2352x1568px
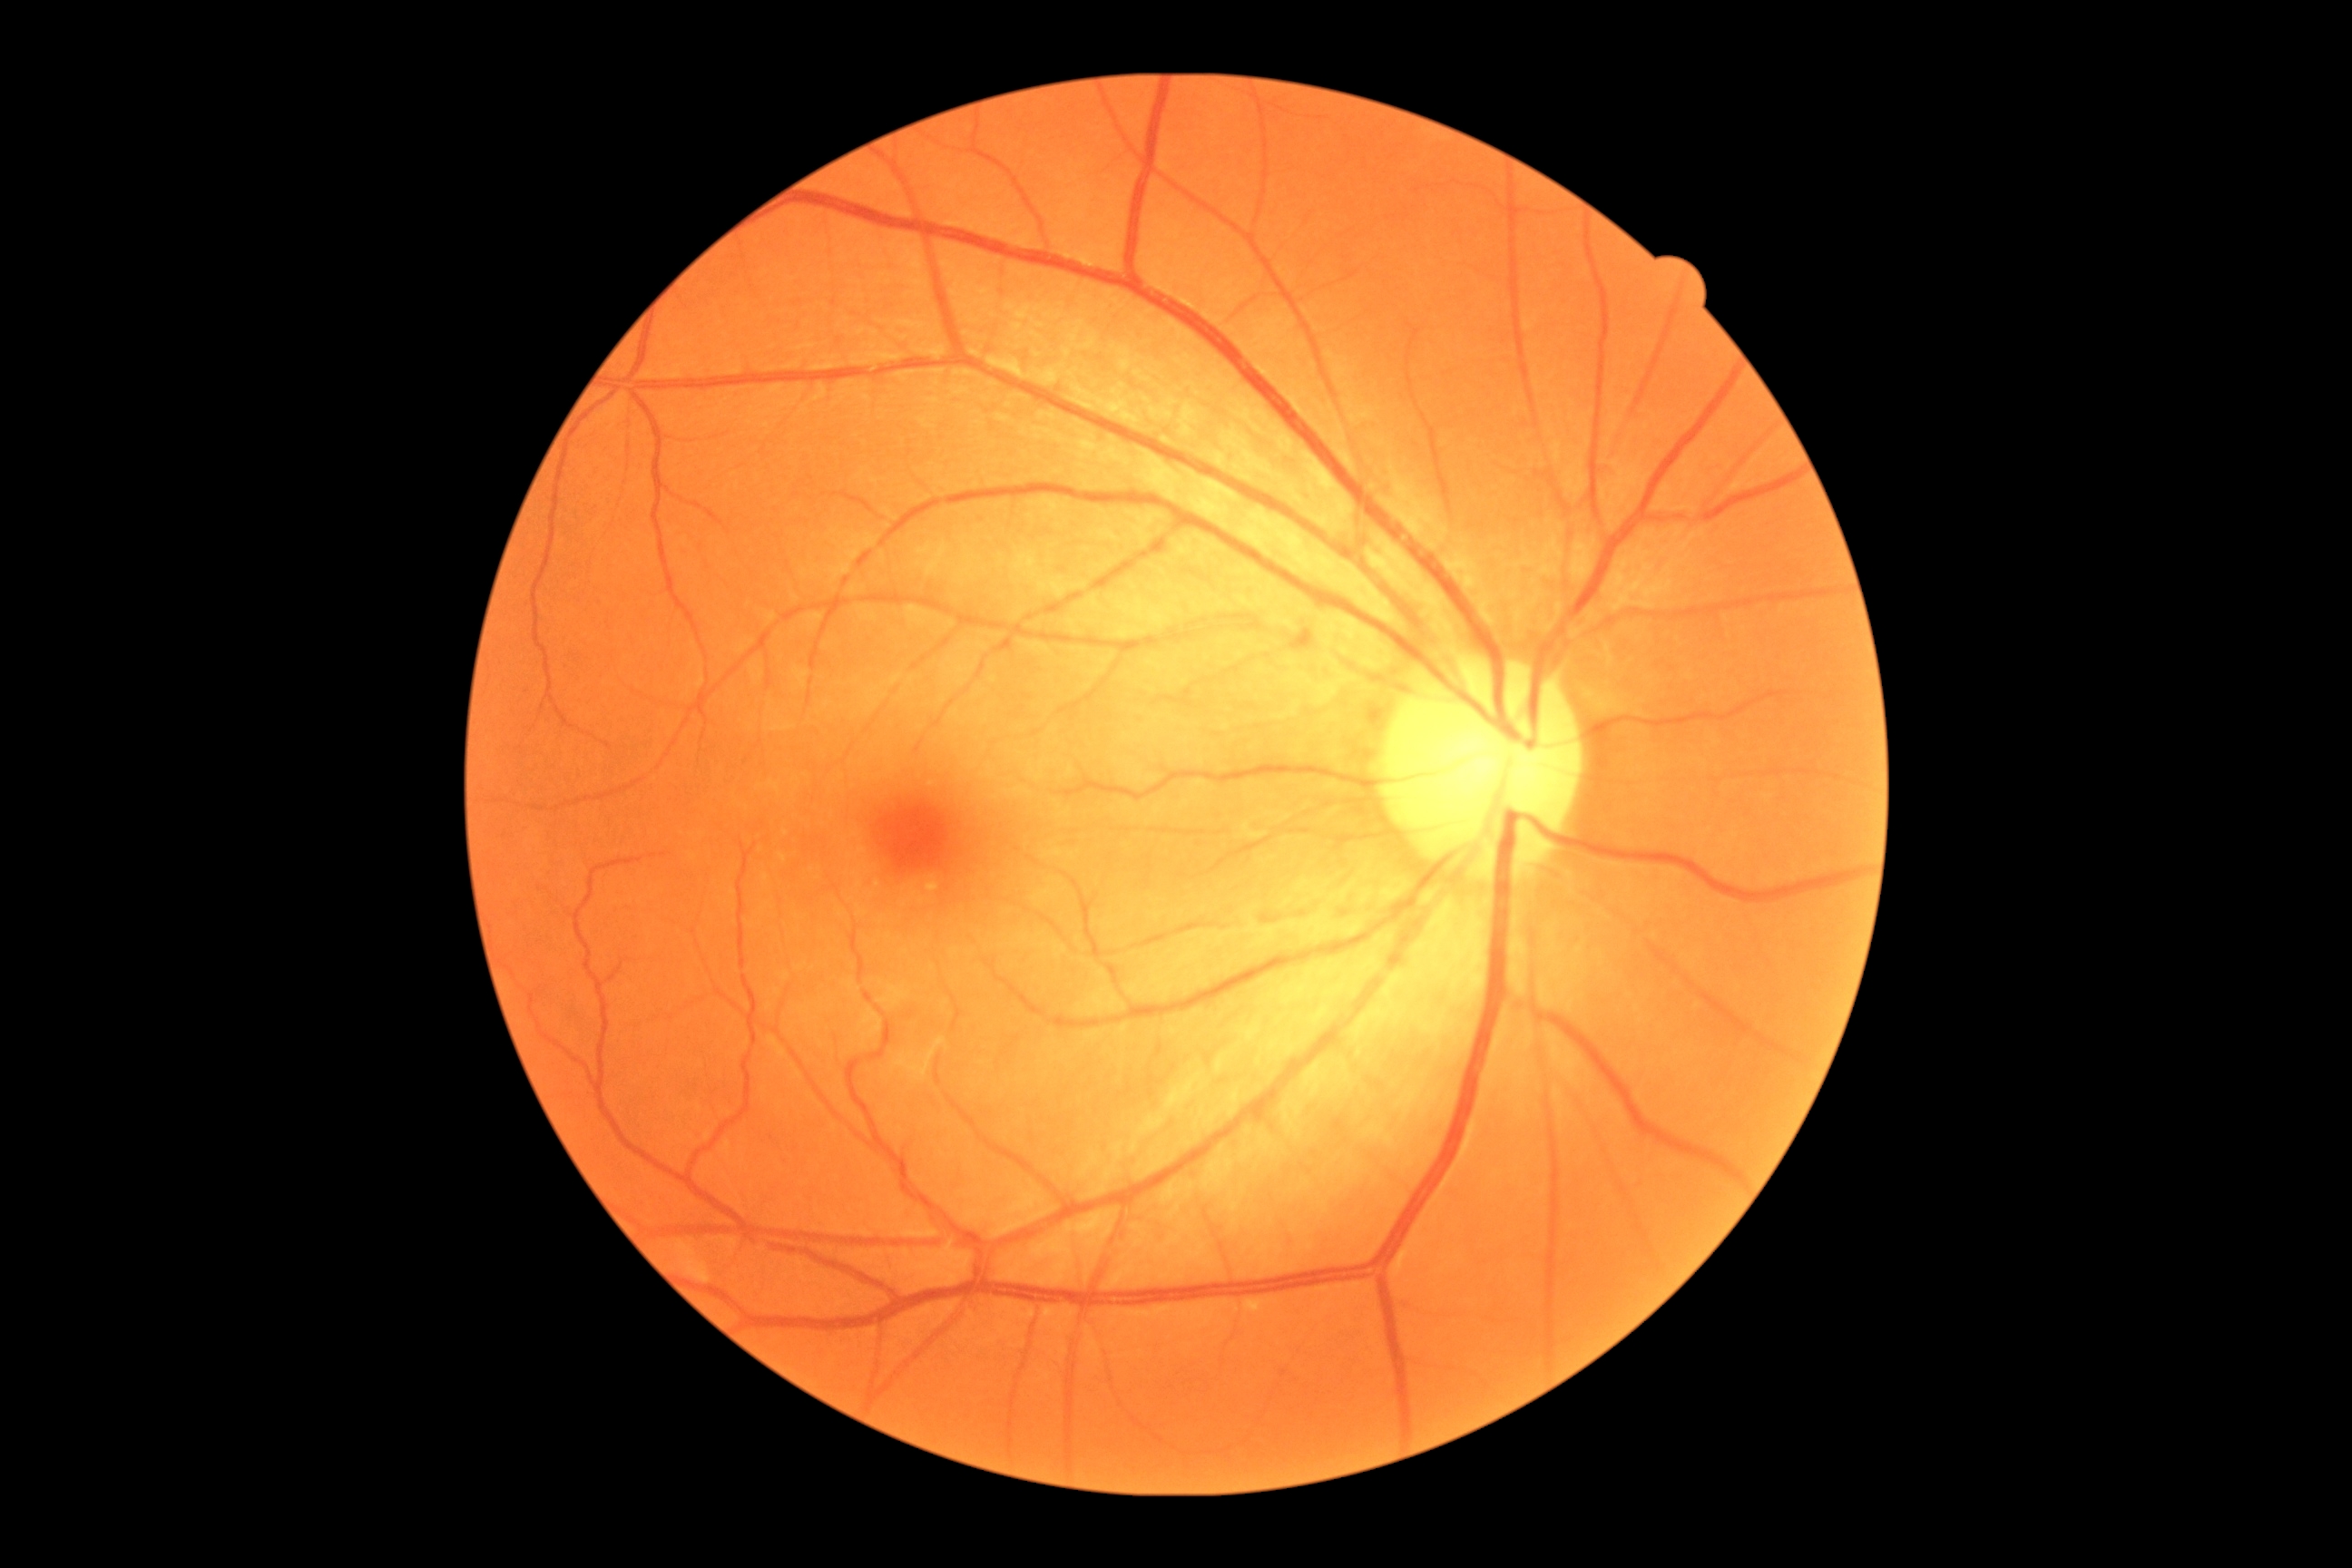 Diabetic retinopathy is grade 0 (no apparent retinopathy).